Graded on the modified Davis scale
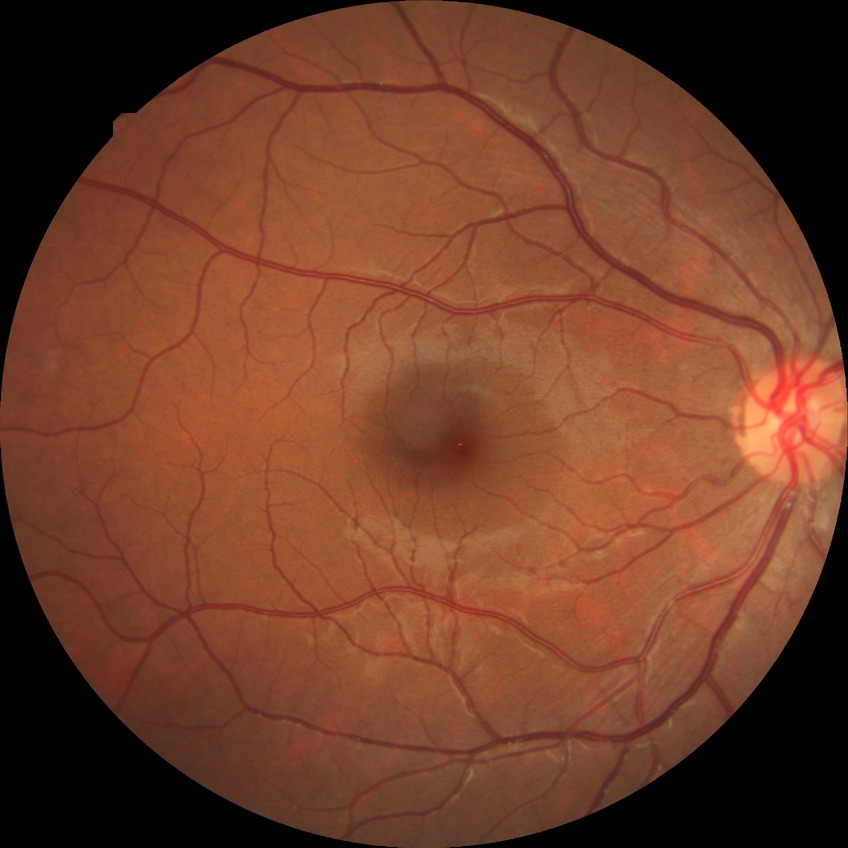
DR stage: NDR.